Infant wide-field fundus photograph; image size 1240x1240 — 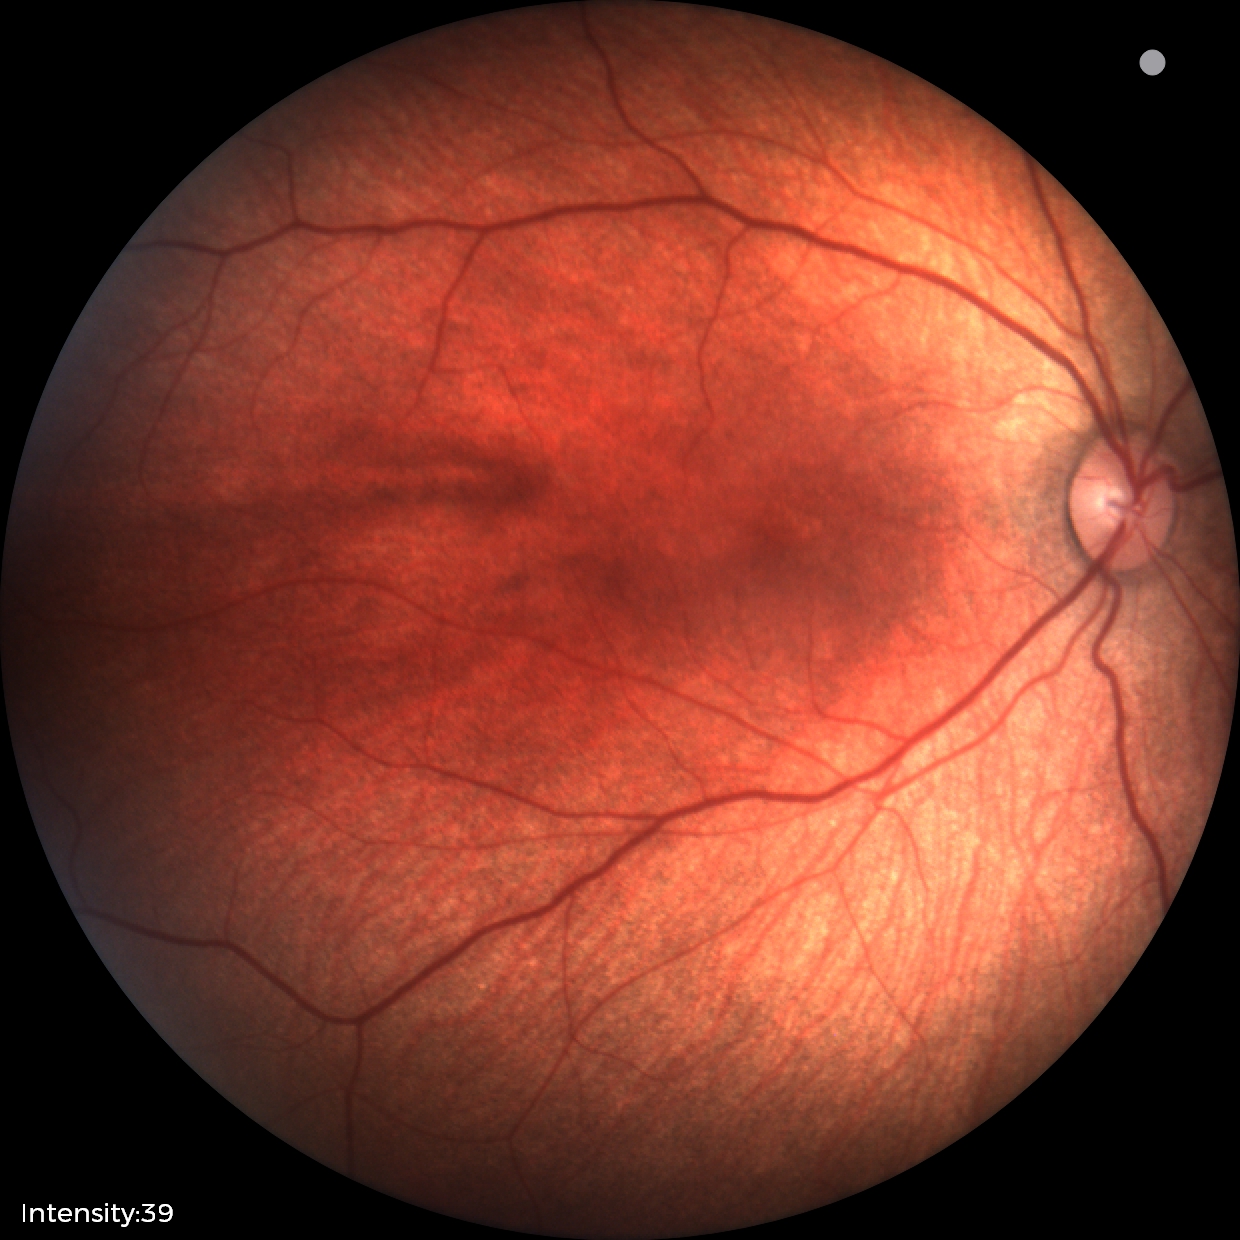
Normal screening examination.